Wide-field contact fundus photograph of an infant
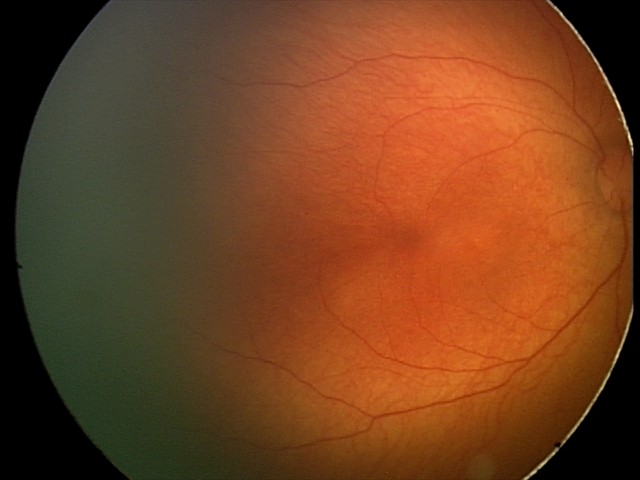

Physiological retinal appearance for postconceptual age.